NIDEK AFC-230 fundus camera; CFP; 848x848px; nonmydriatic; FOV: 45 degrees; modified Davis grading:
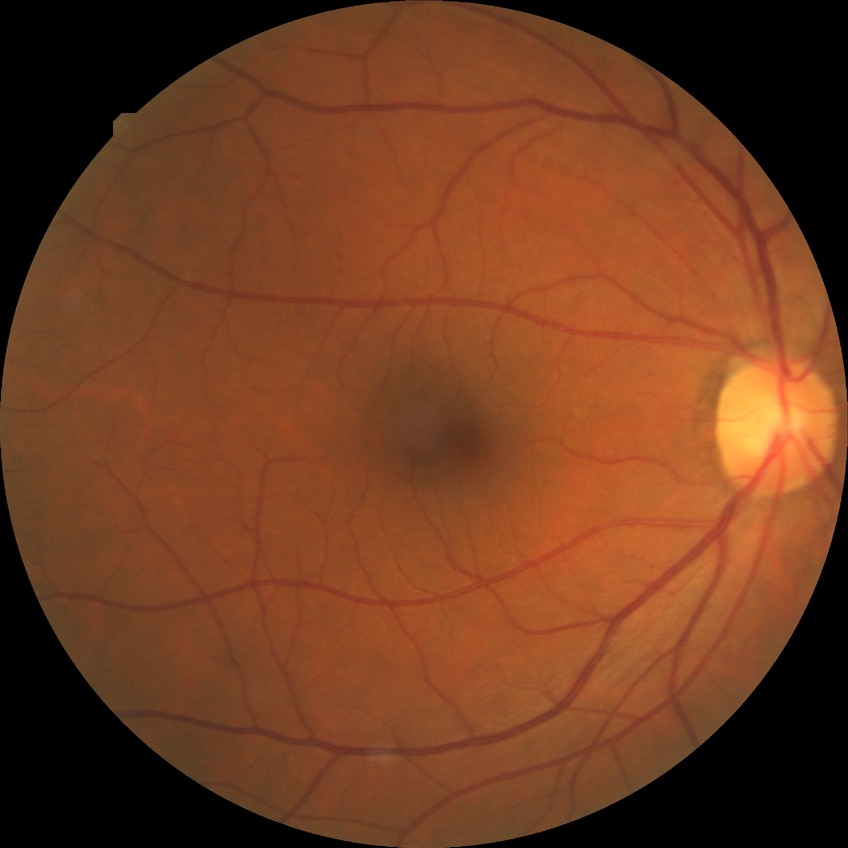
No DR findings.
DR stage is NDR.